45° FOV.
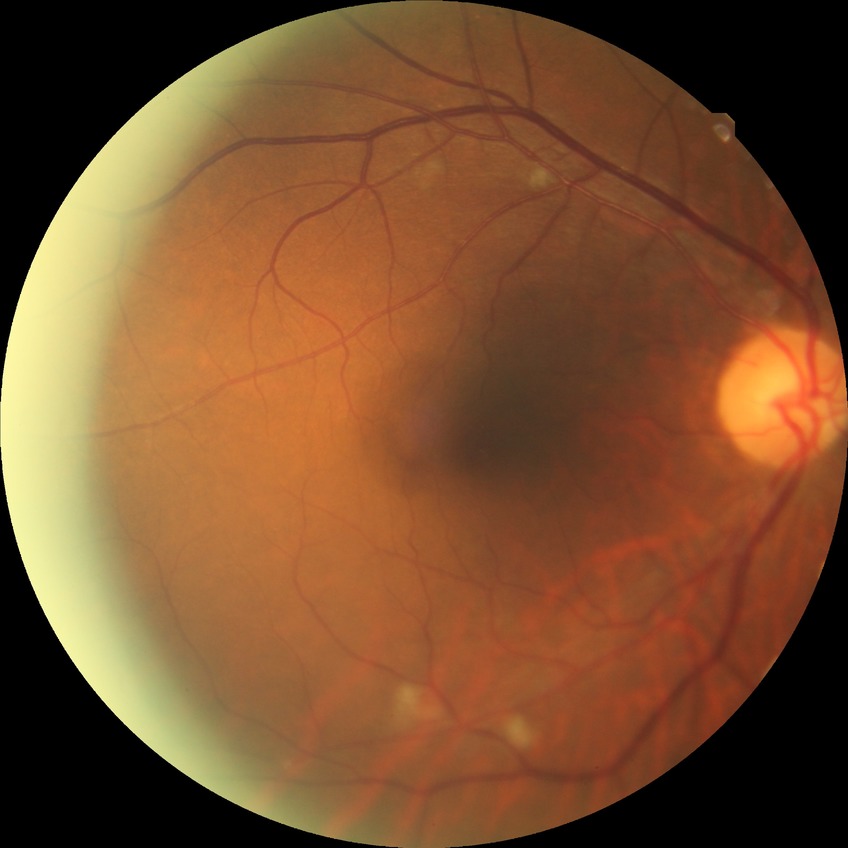

Diabetic retinopathy severity is pre-proliferative diabetic retinopathy.